45° field of view.
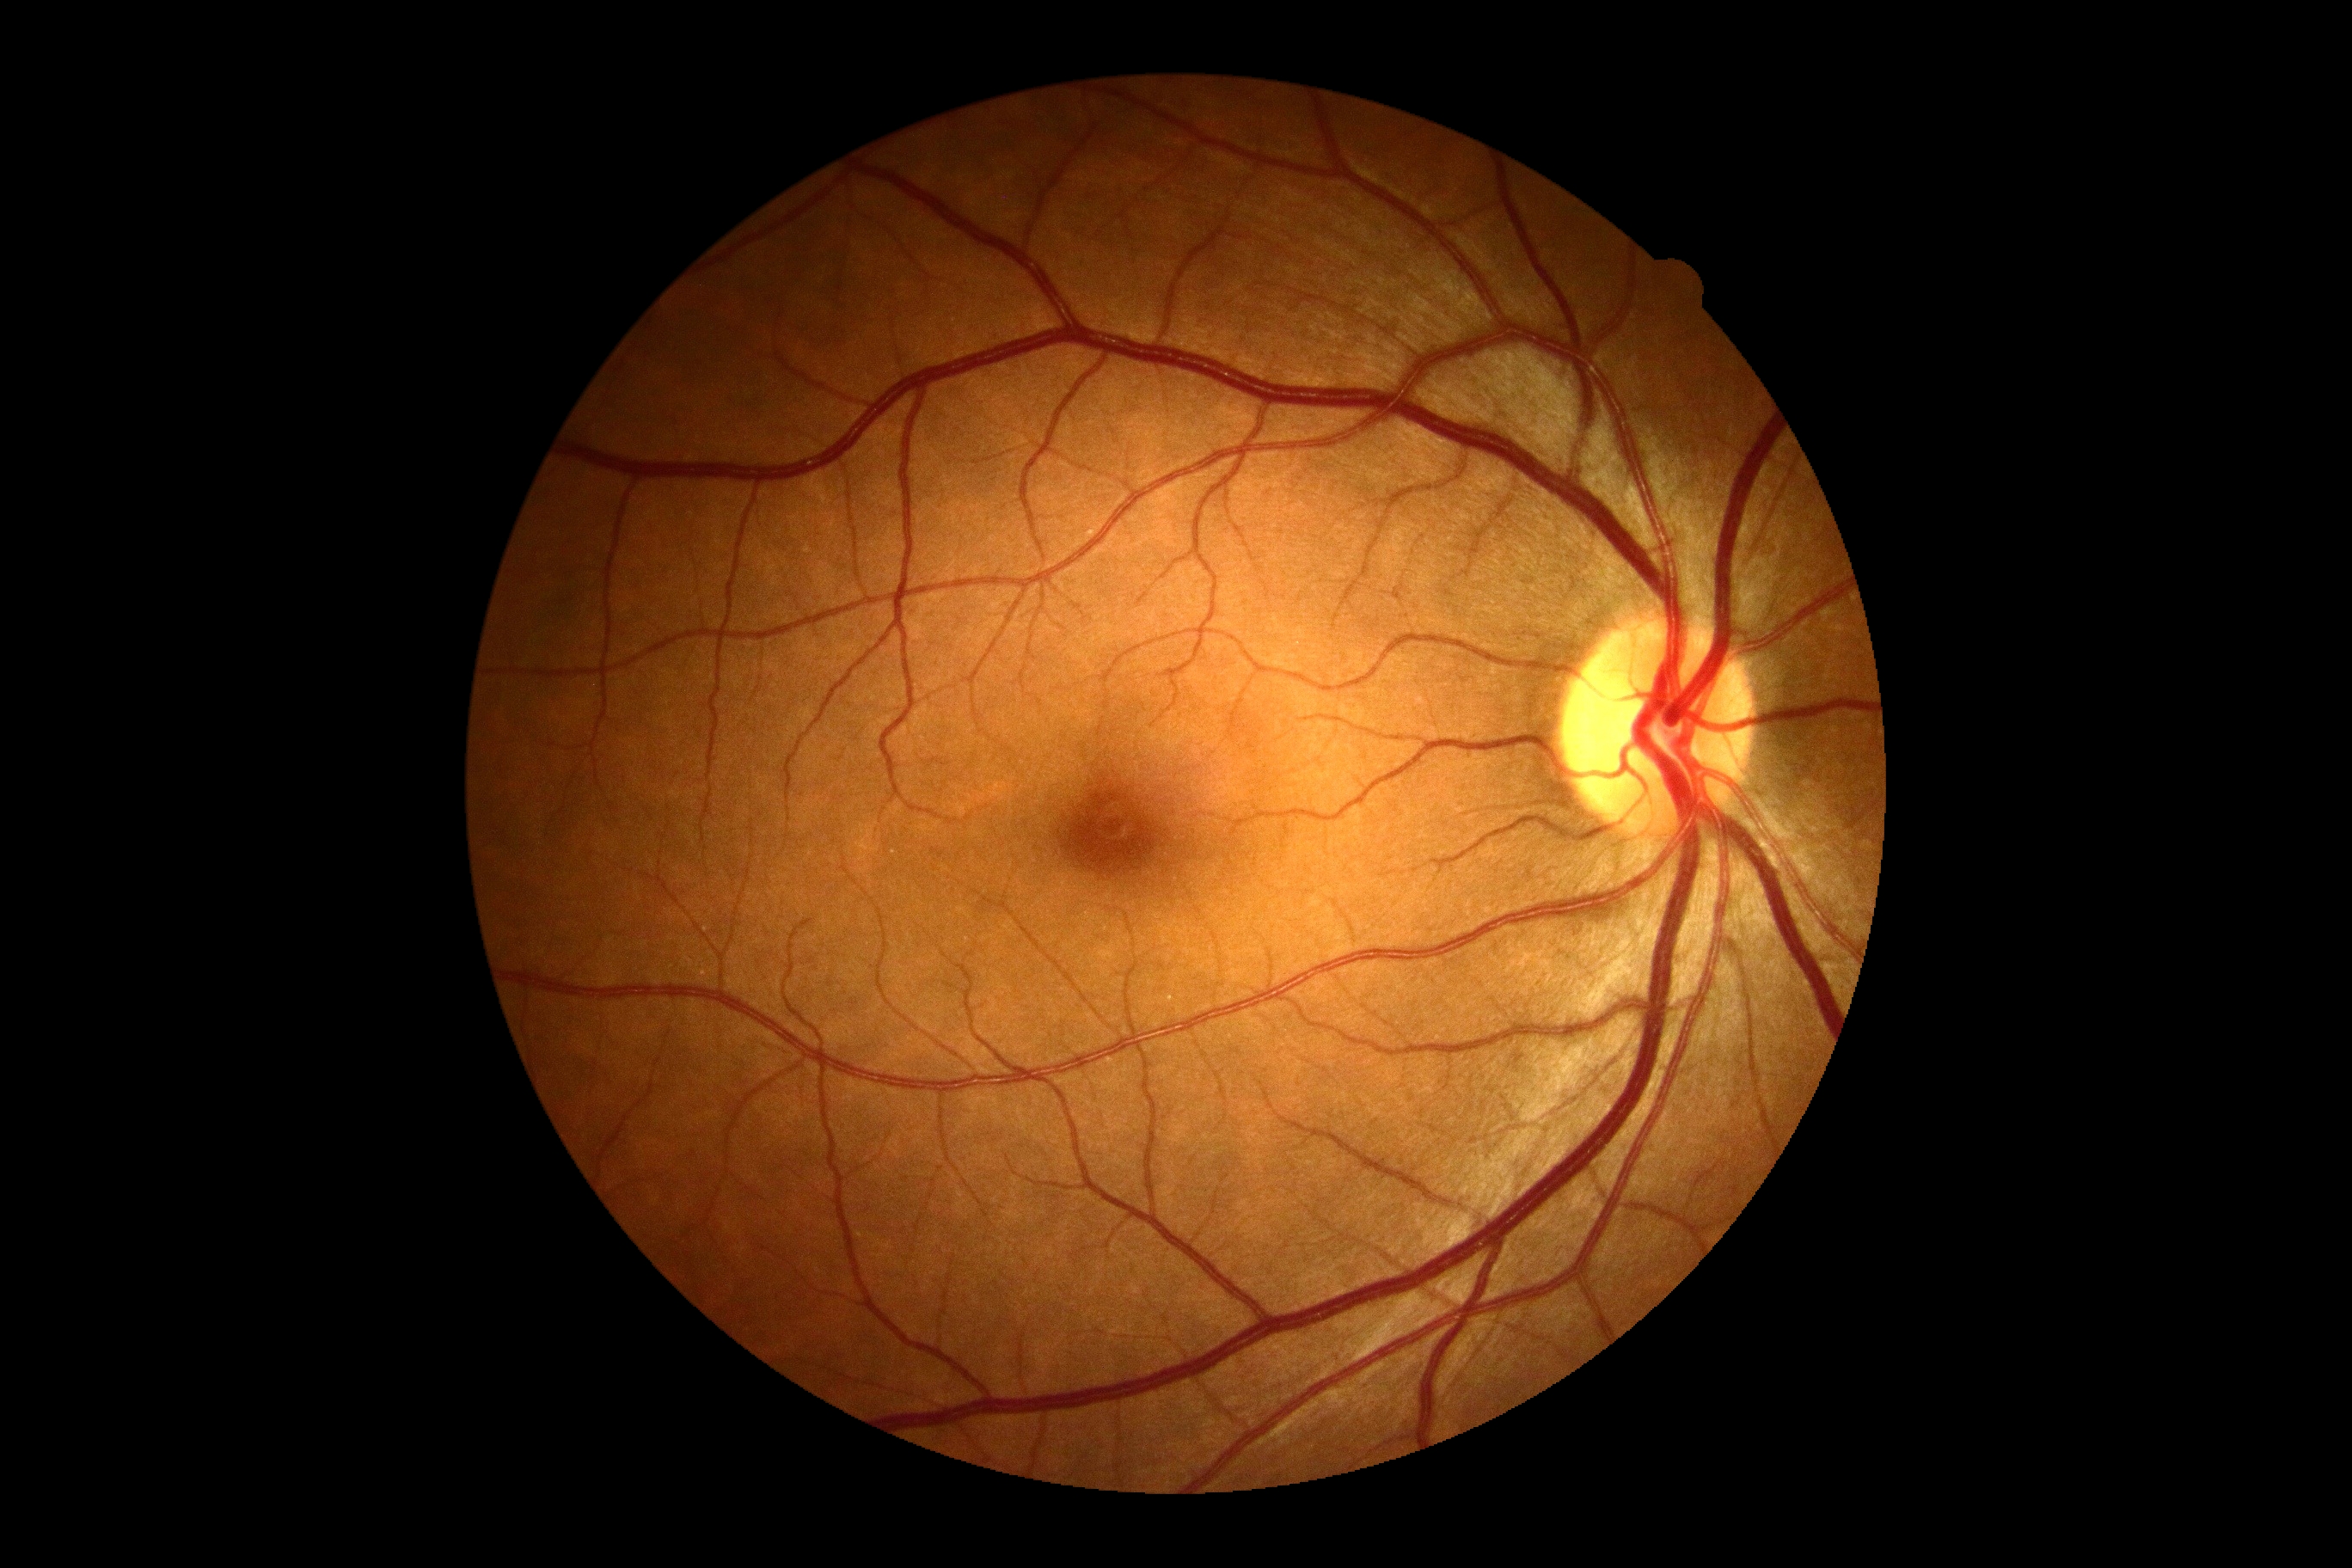

diabetic retinopathy grade: 0 (no apparent retinopathy).